Modified Davis grading; 848x848px; fundus photo; camera: NIDEK AFC-230:
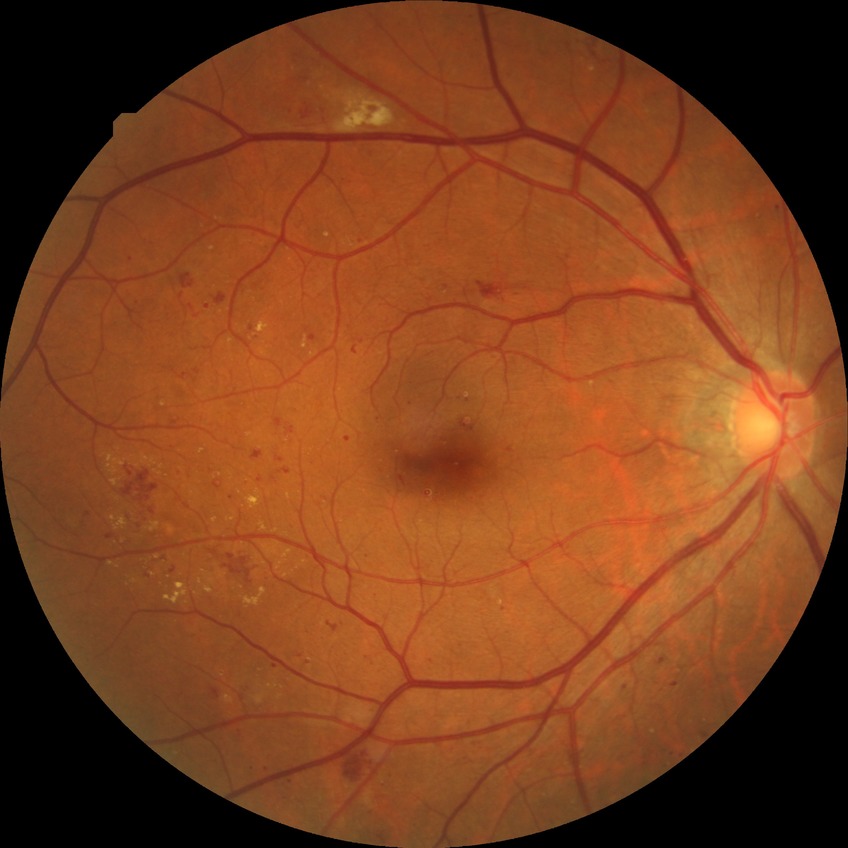

Diabetic retinopathy severity: pre-proliferative diabetic retinopathy.